Captured on a Topcon TRC-50DX fundus camera — 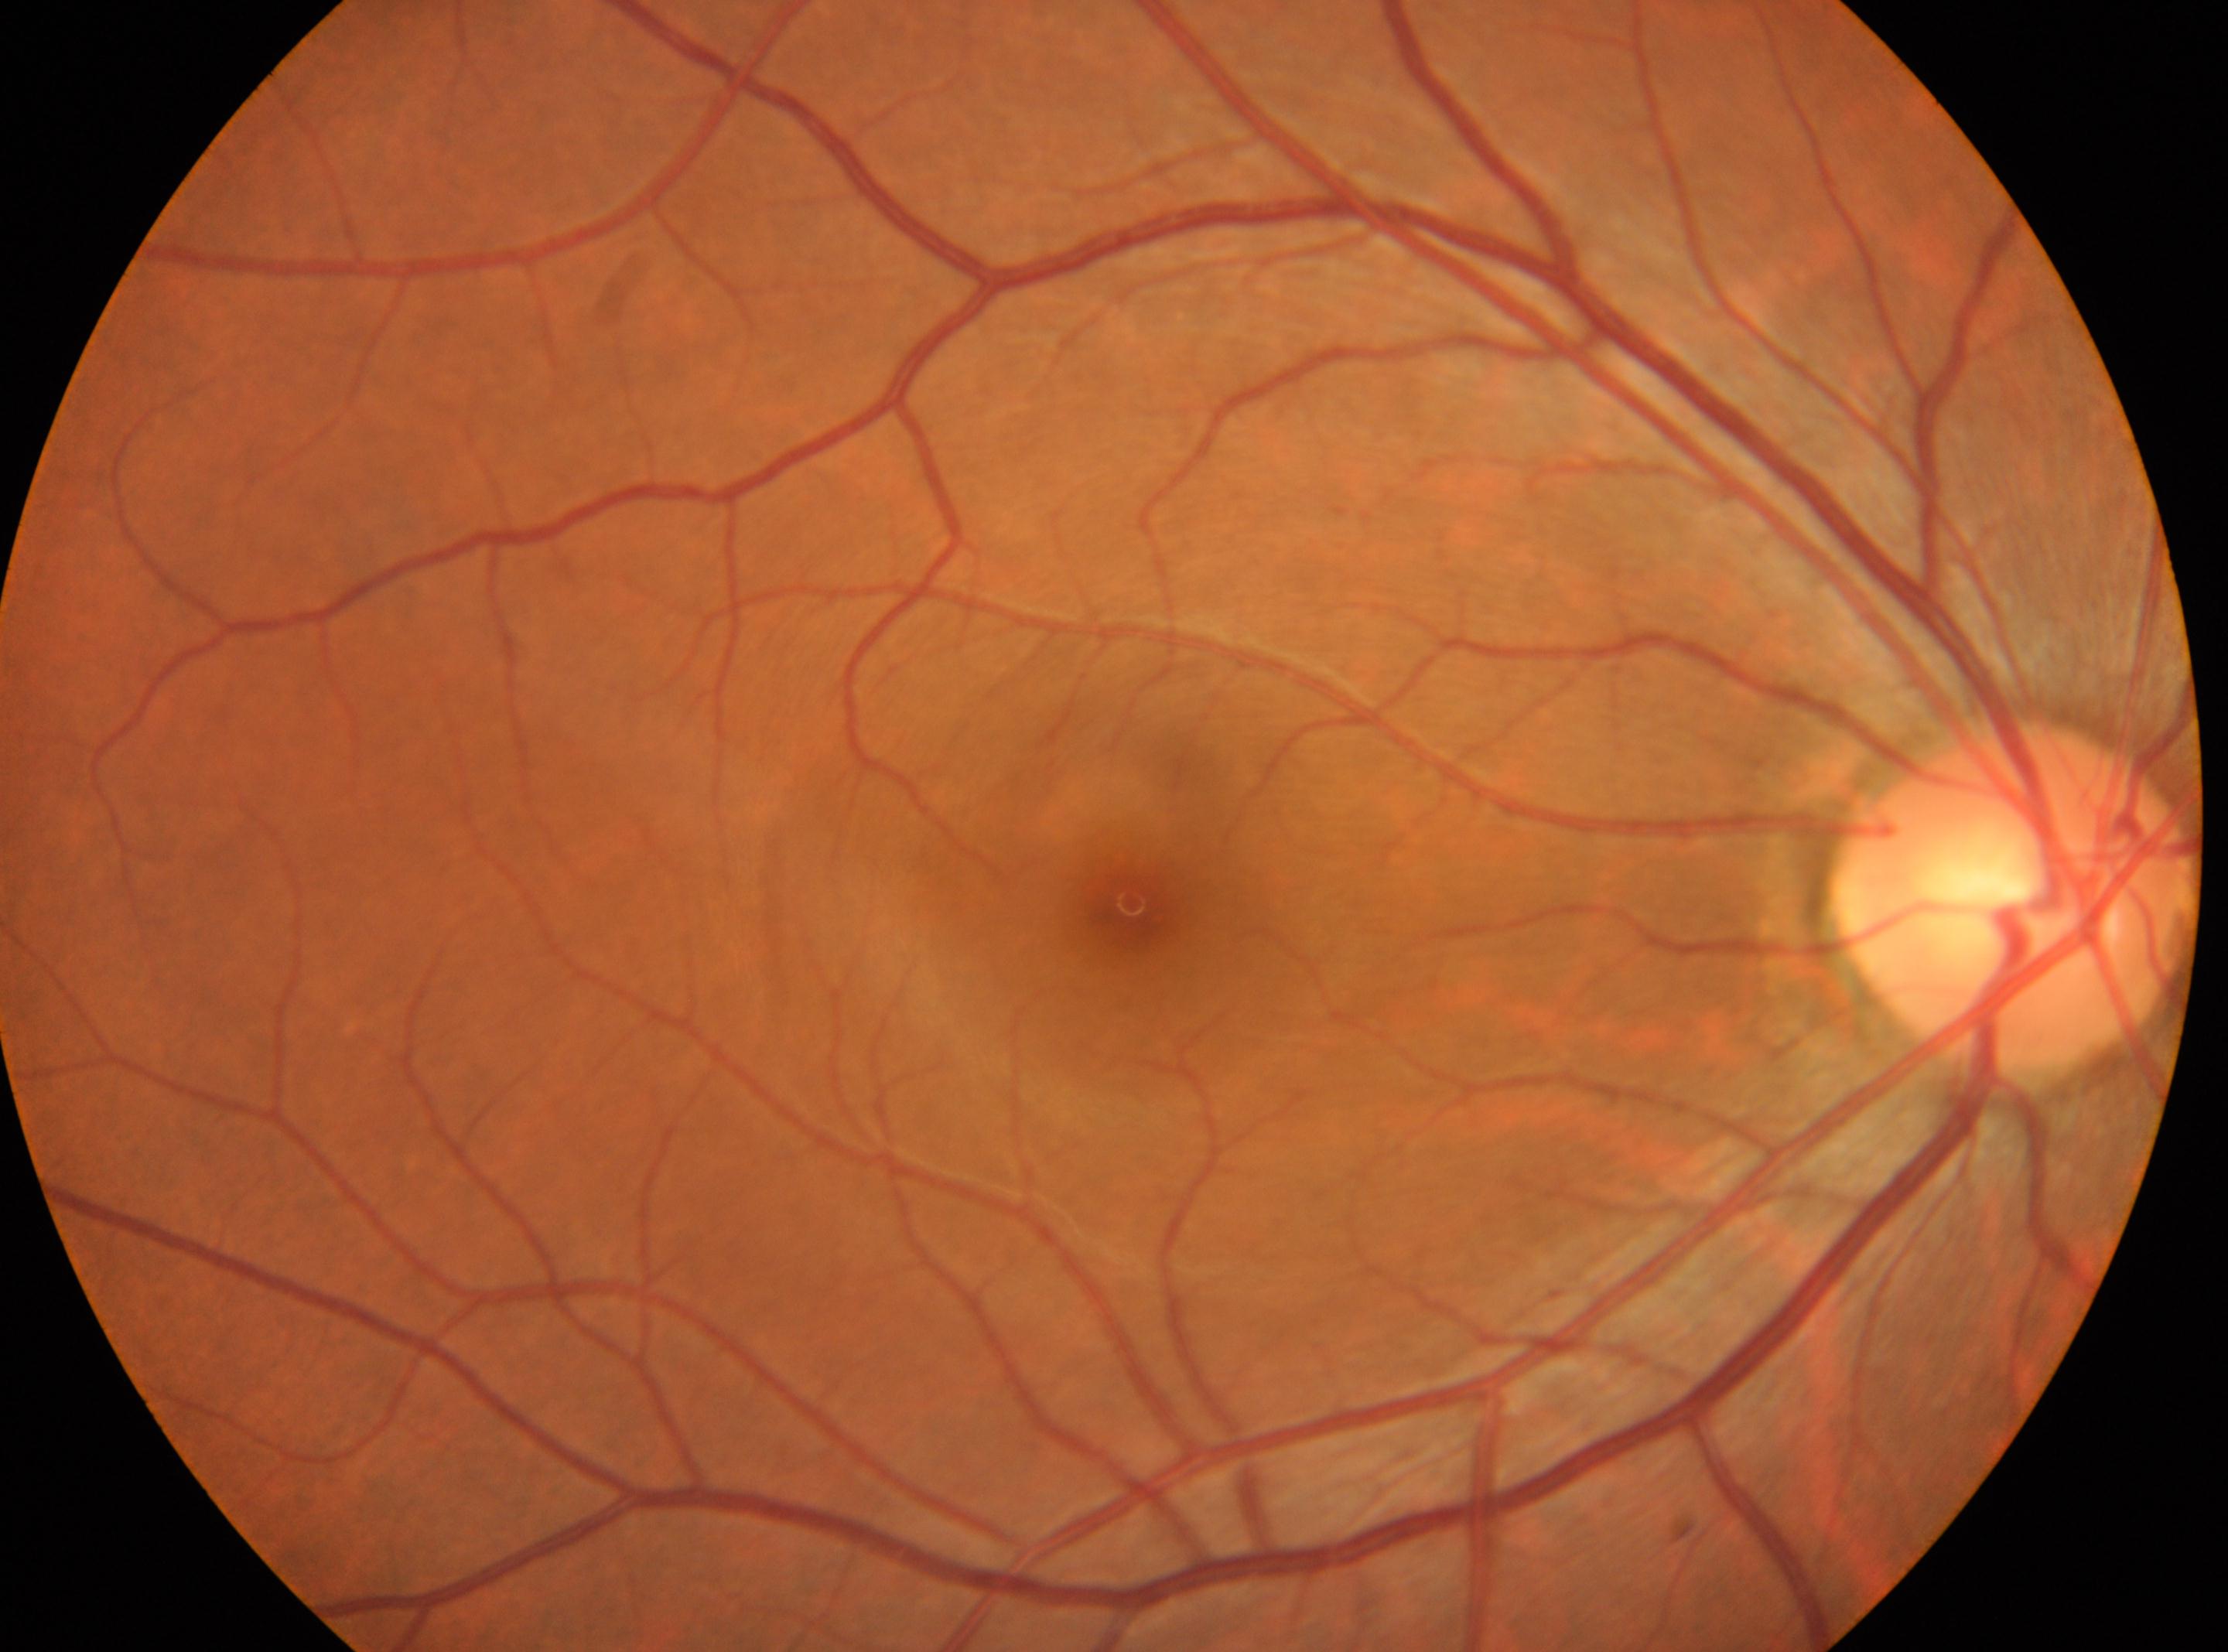 diabetic retinopathy grade: no apparent retinopathy (0) | macular center: [1129, 902] | the optic disc: [2011, 897] | oculus dexter | No DR findings.